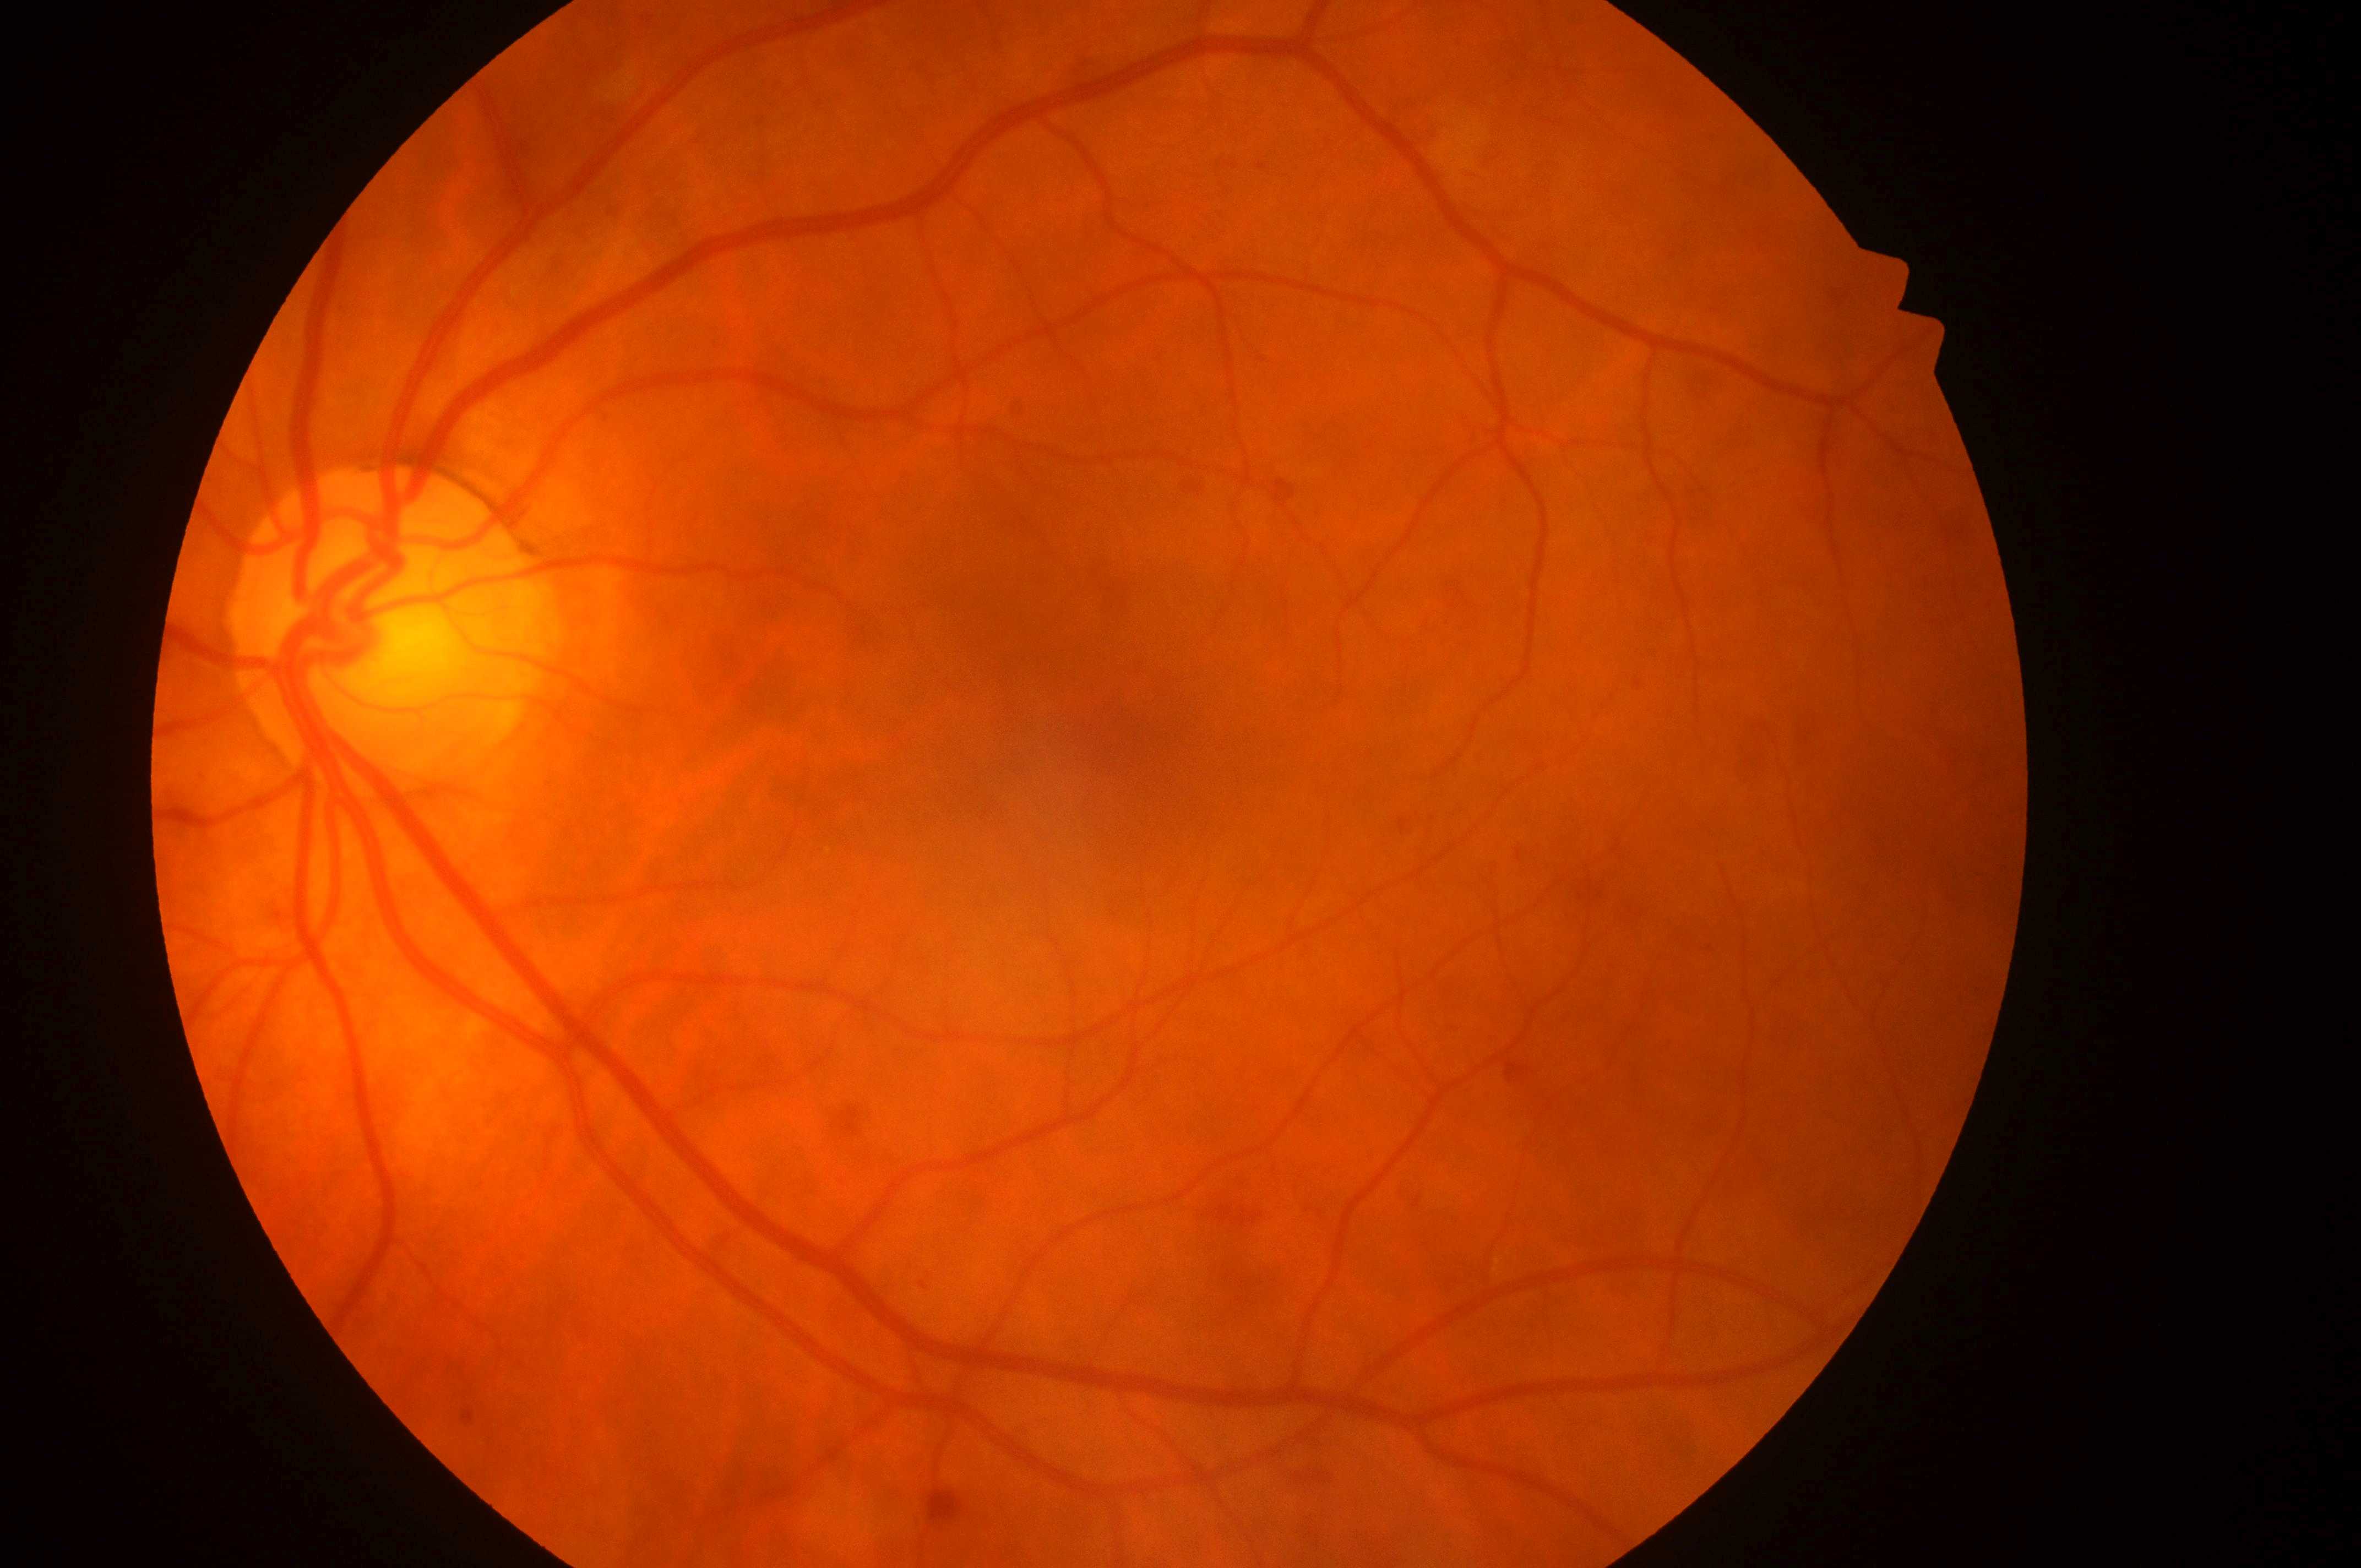

DME: 0.
The fovea centralis is at [1095, 727].
The image shows the left eye.
Optic nerve head located at [377, 639].
DR severity is grade 2.